RetCam wide-field infant fundus image: 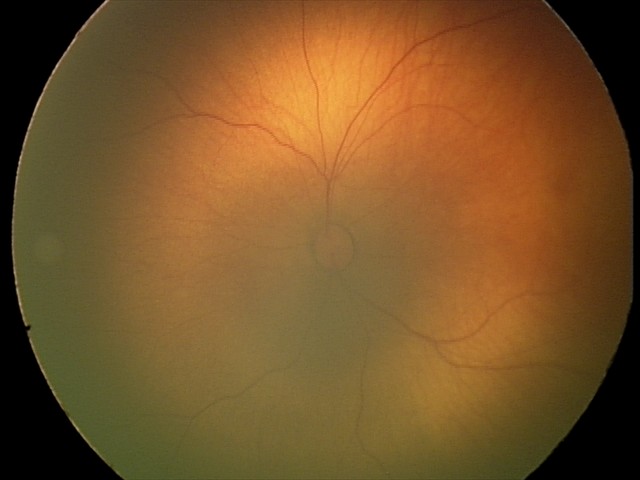

Assessment: no abnormalities.